CFP
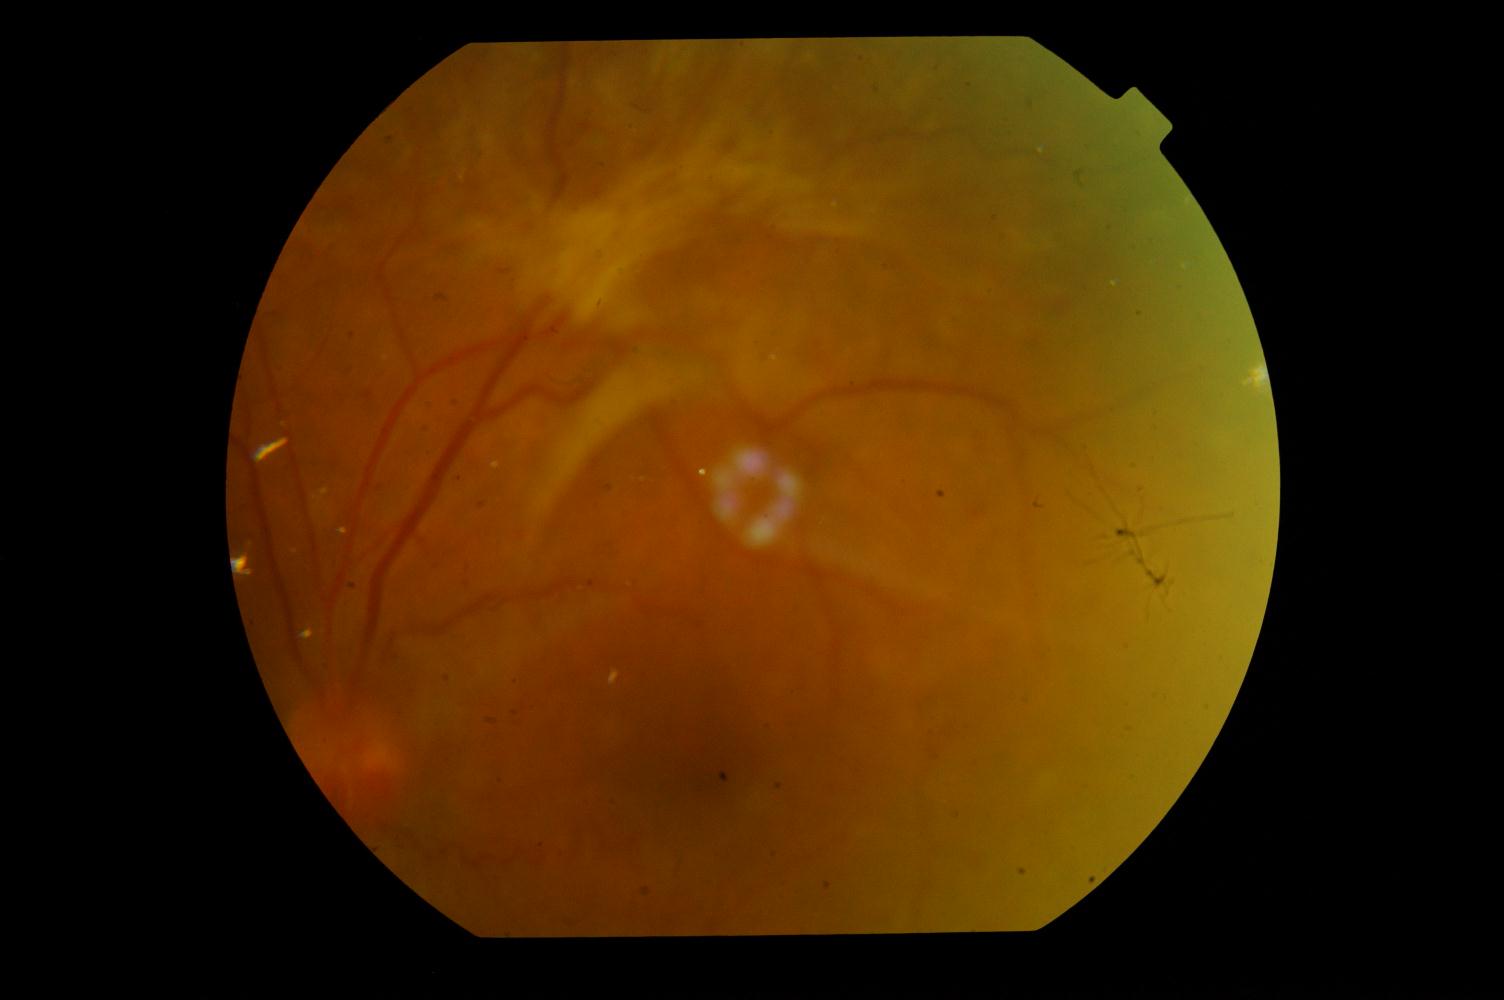 Findings:
- diabetic retinopathy